NIDEK AFC-230 fundus camera, nonmydriatic fundus photograph
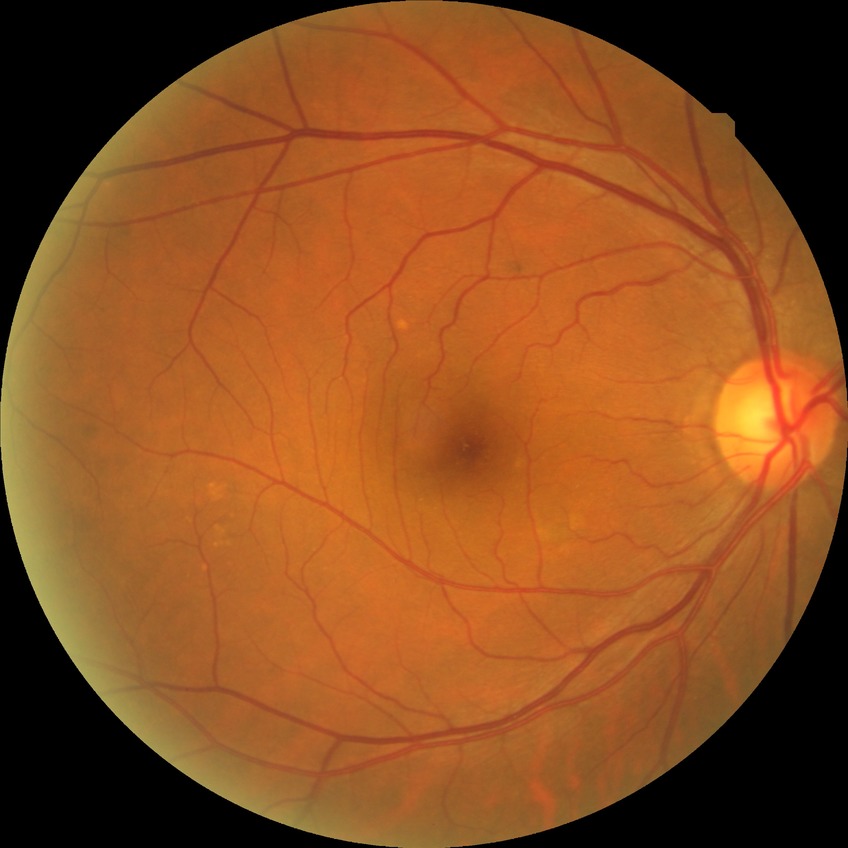

diabetic retinopathy (DR)@NDR (no diabetic retinopathy).